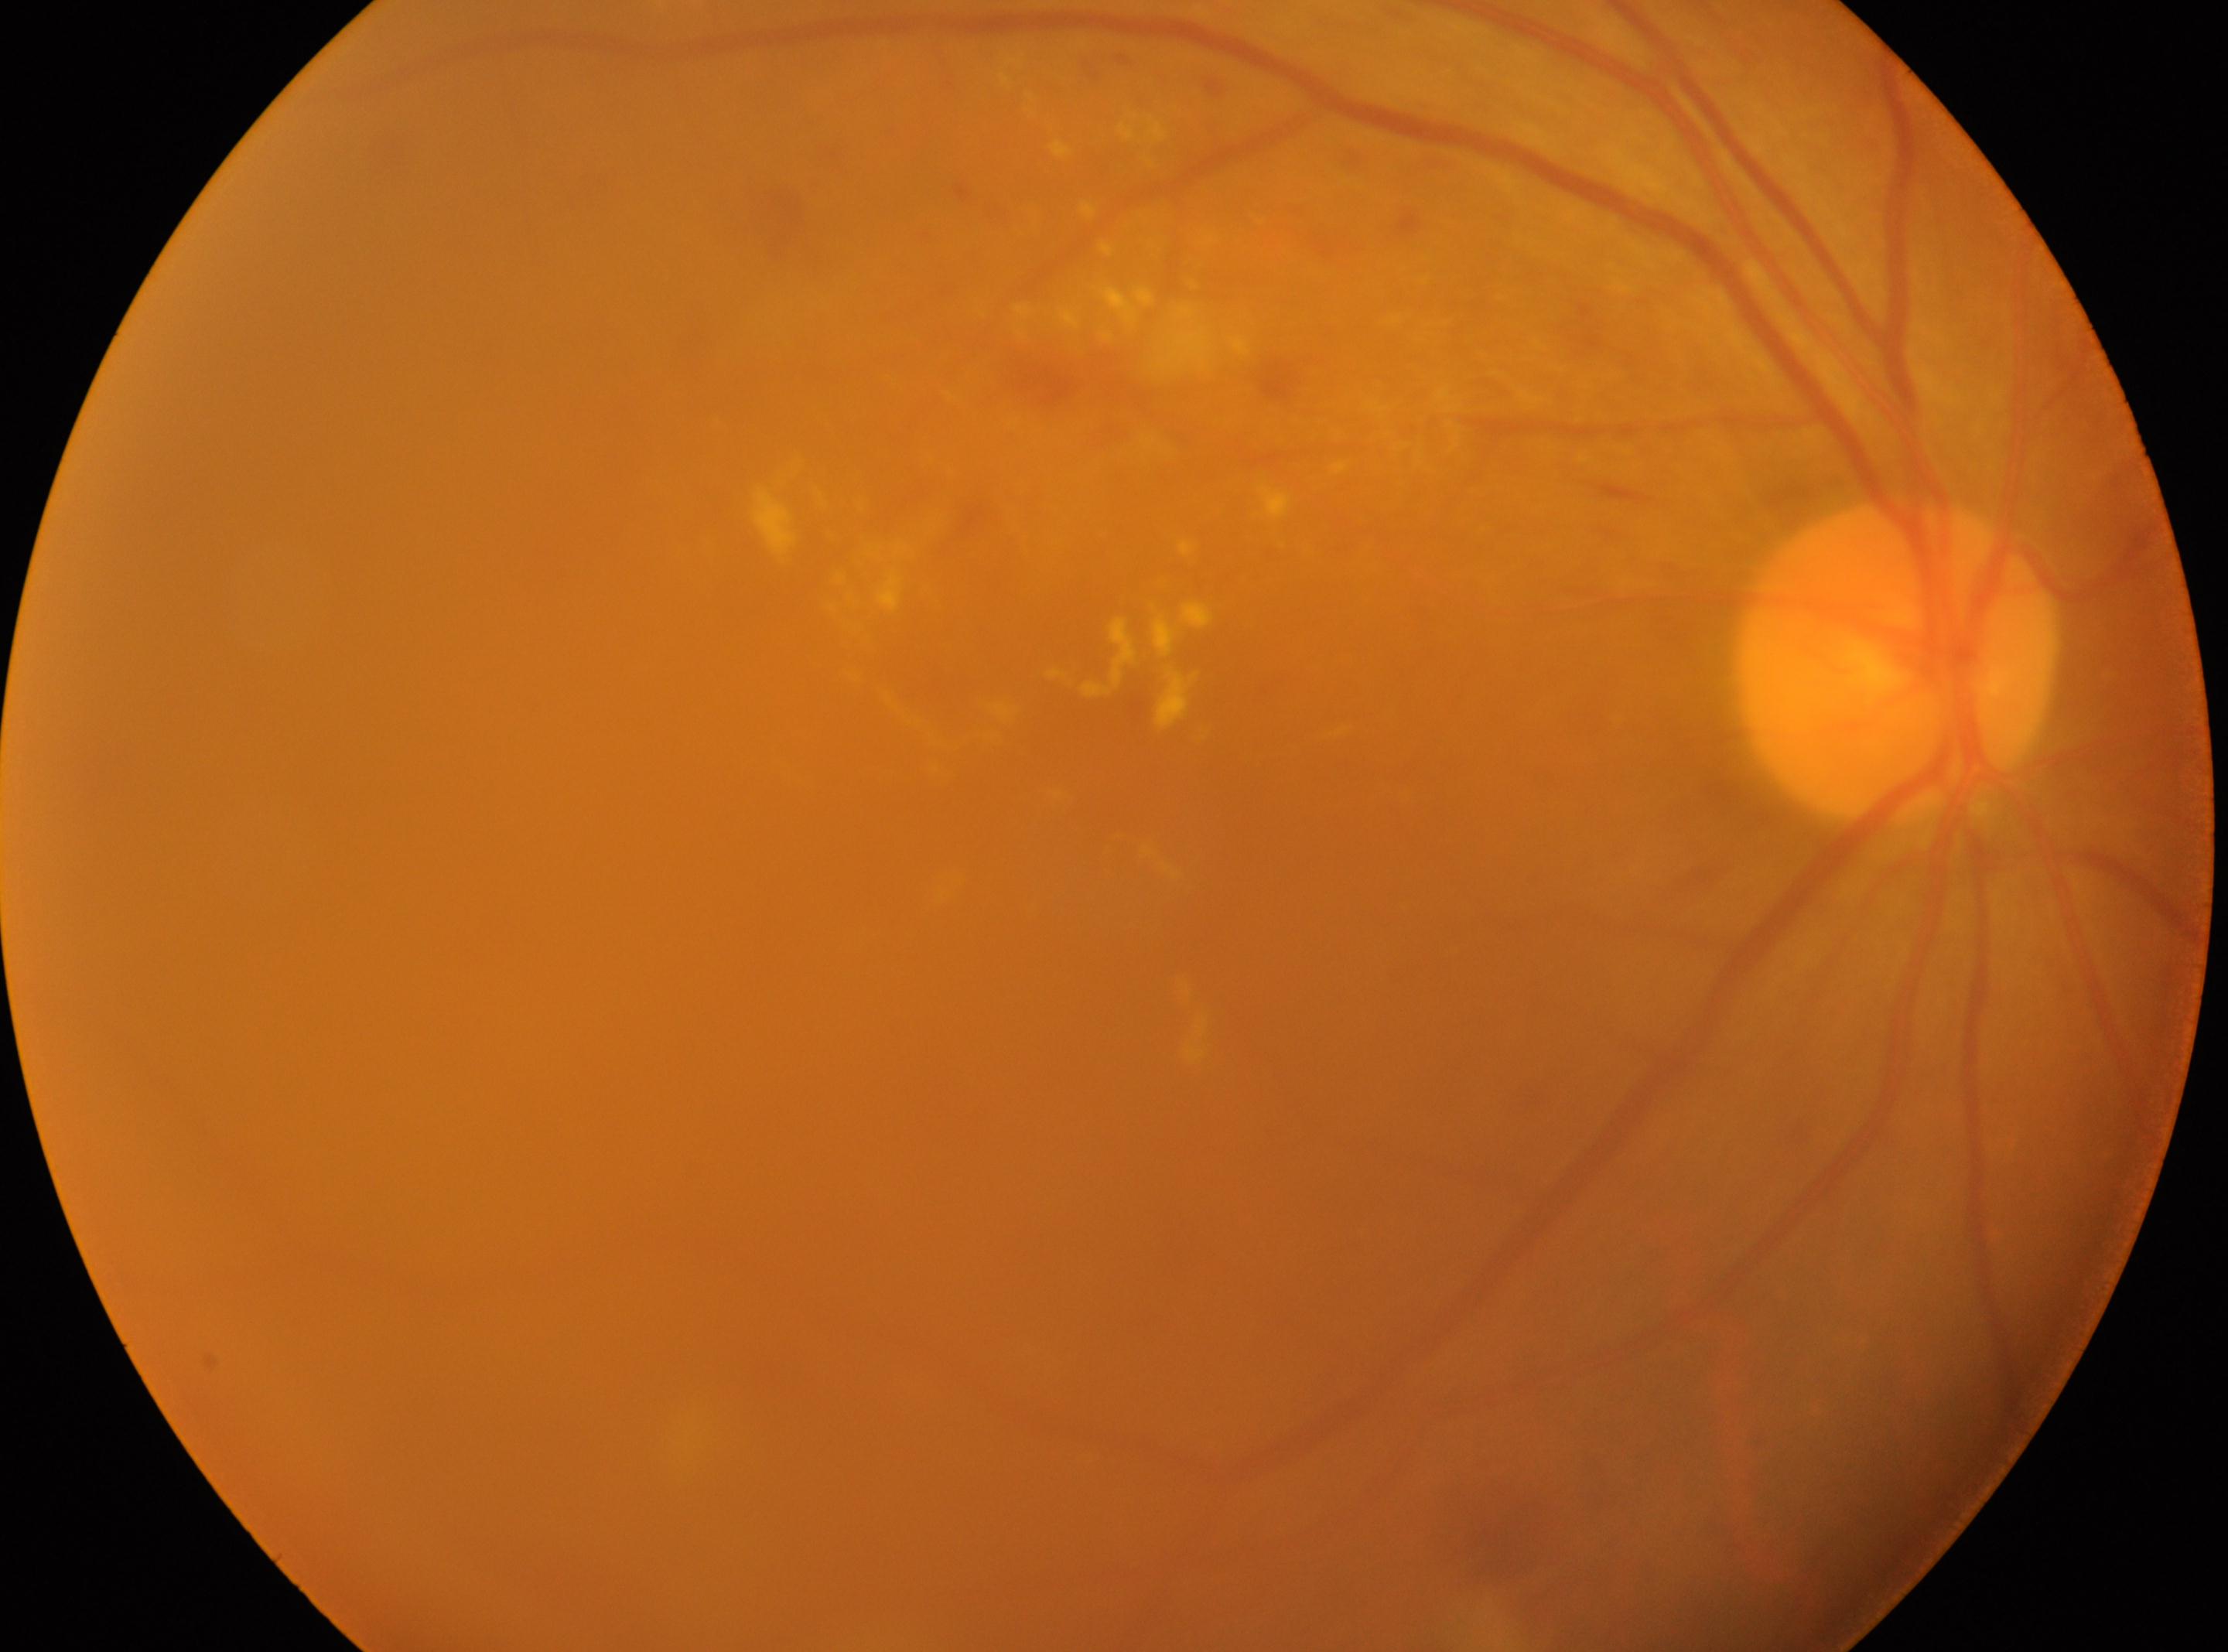
Findings:
* optic disk · (x=1896, y=658)
* macular center · (x=1091, y=798)
* laterality · the right eye
* DR severity · moderate non-proliferative diabetic retinopathy (grade 2)